45° field of view; 2048x1536; retinal fundus photograph.
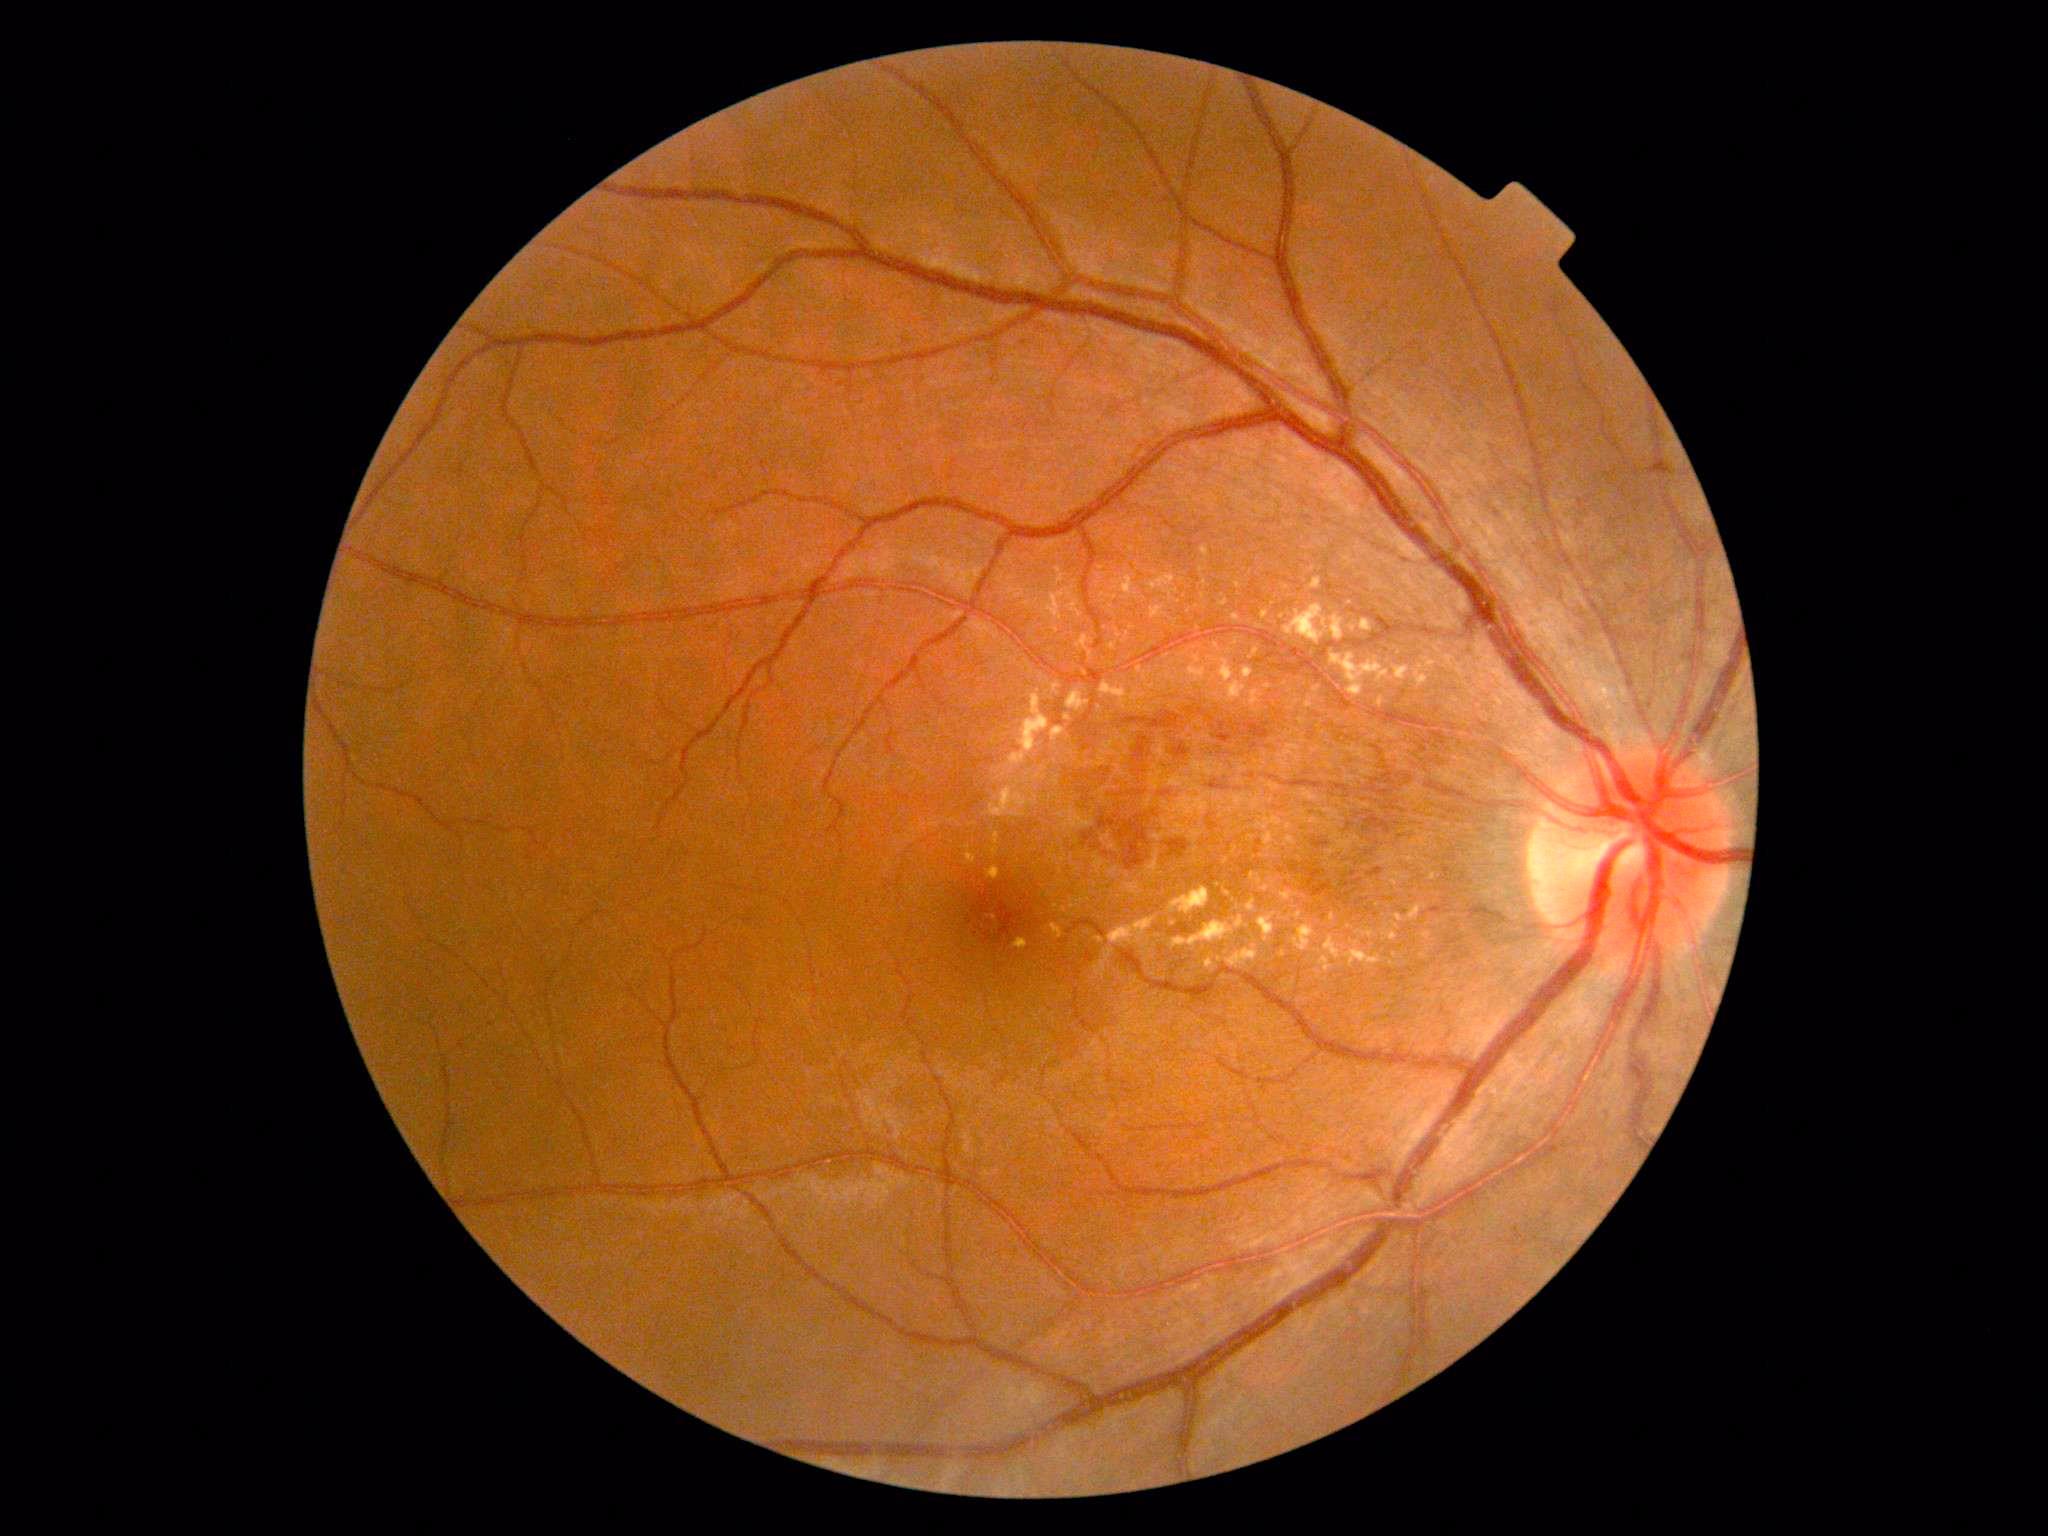
DR class=non-proliferative diabetic retinopathy, DR grade=moderate non-proliferative diabetic retinopathy (2).